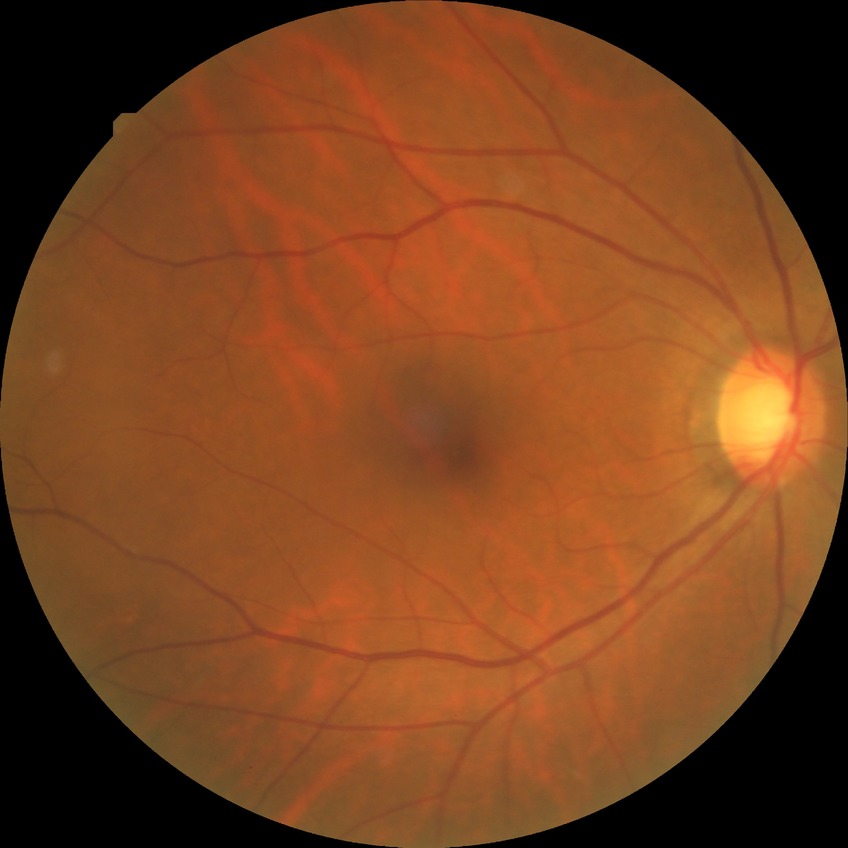

Diabetic retinopathy grade: no diabetic retinopathy.